Wide-field contact fundus photograph of an infant. Phoenix ICON, 100° FOV — 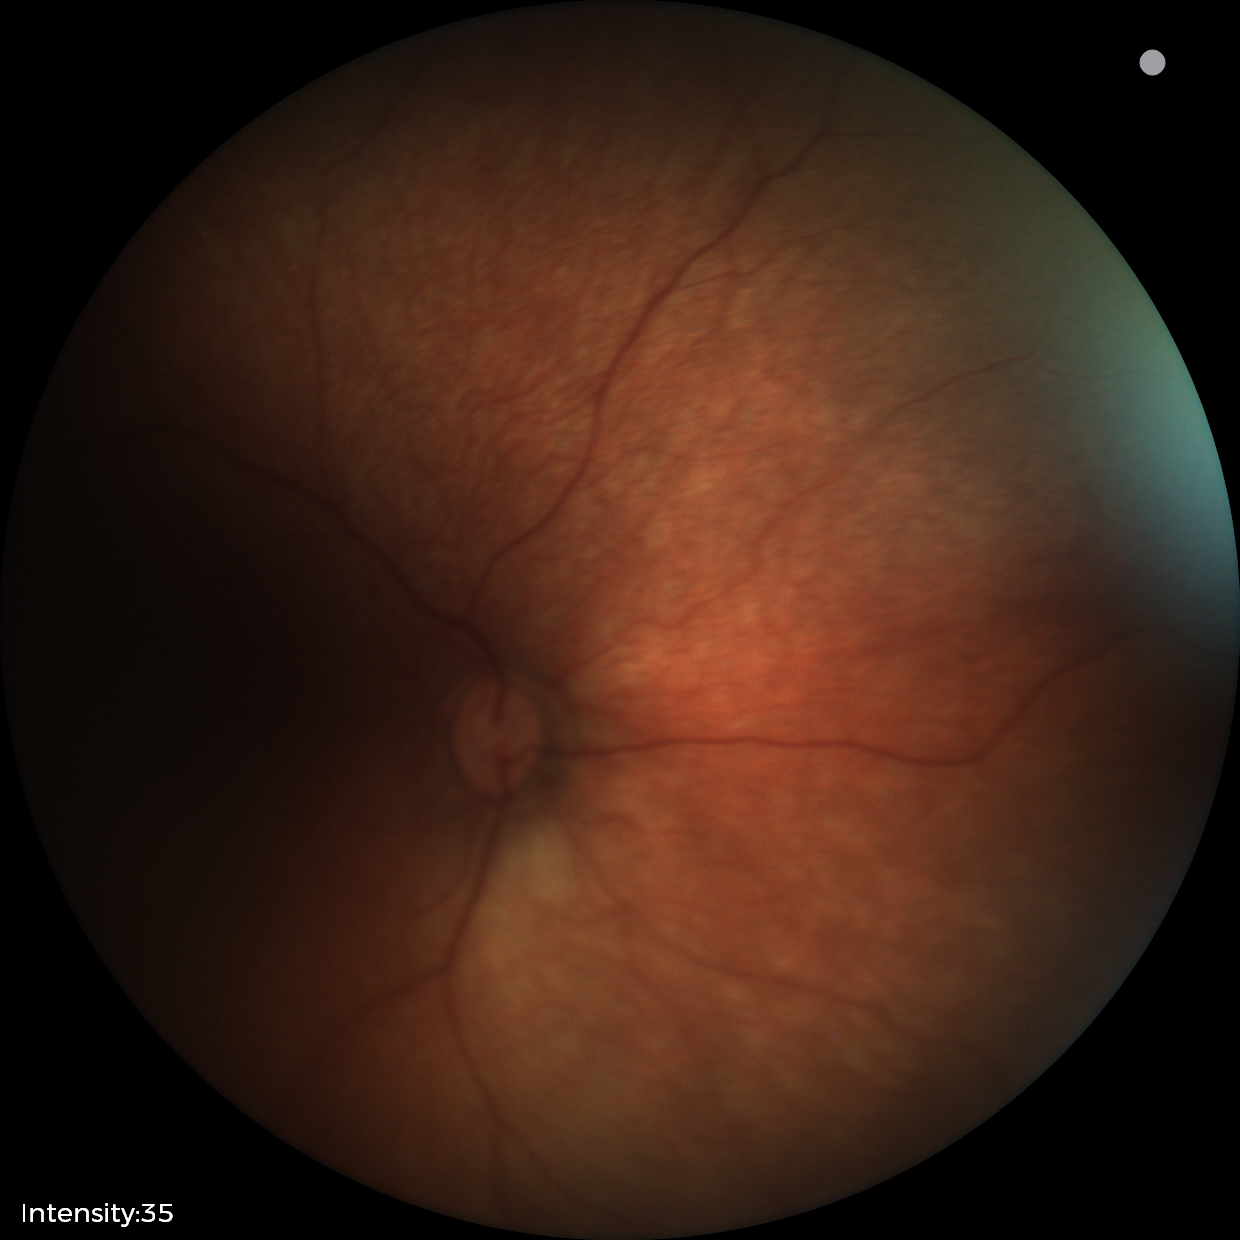

Screening examination with no abnormal retinal findings.